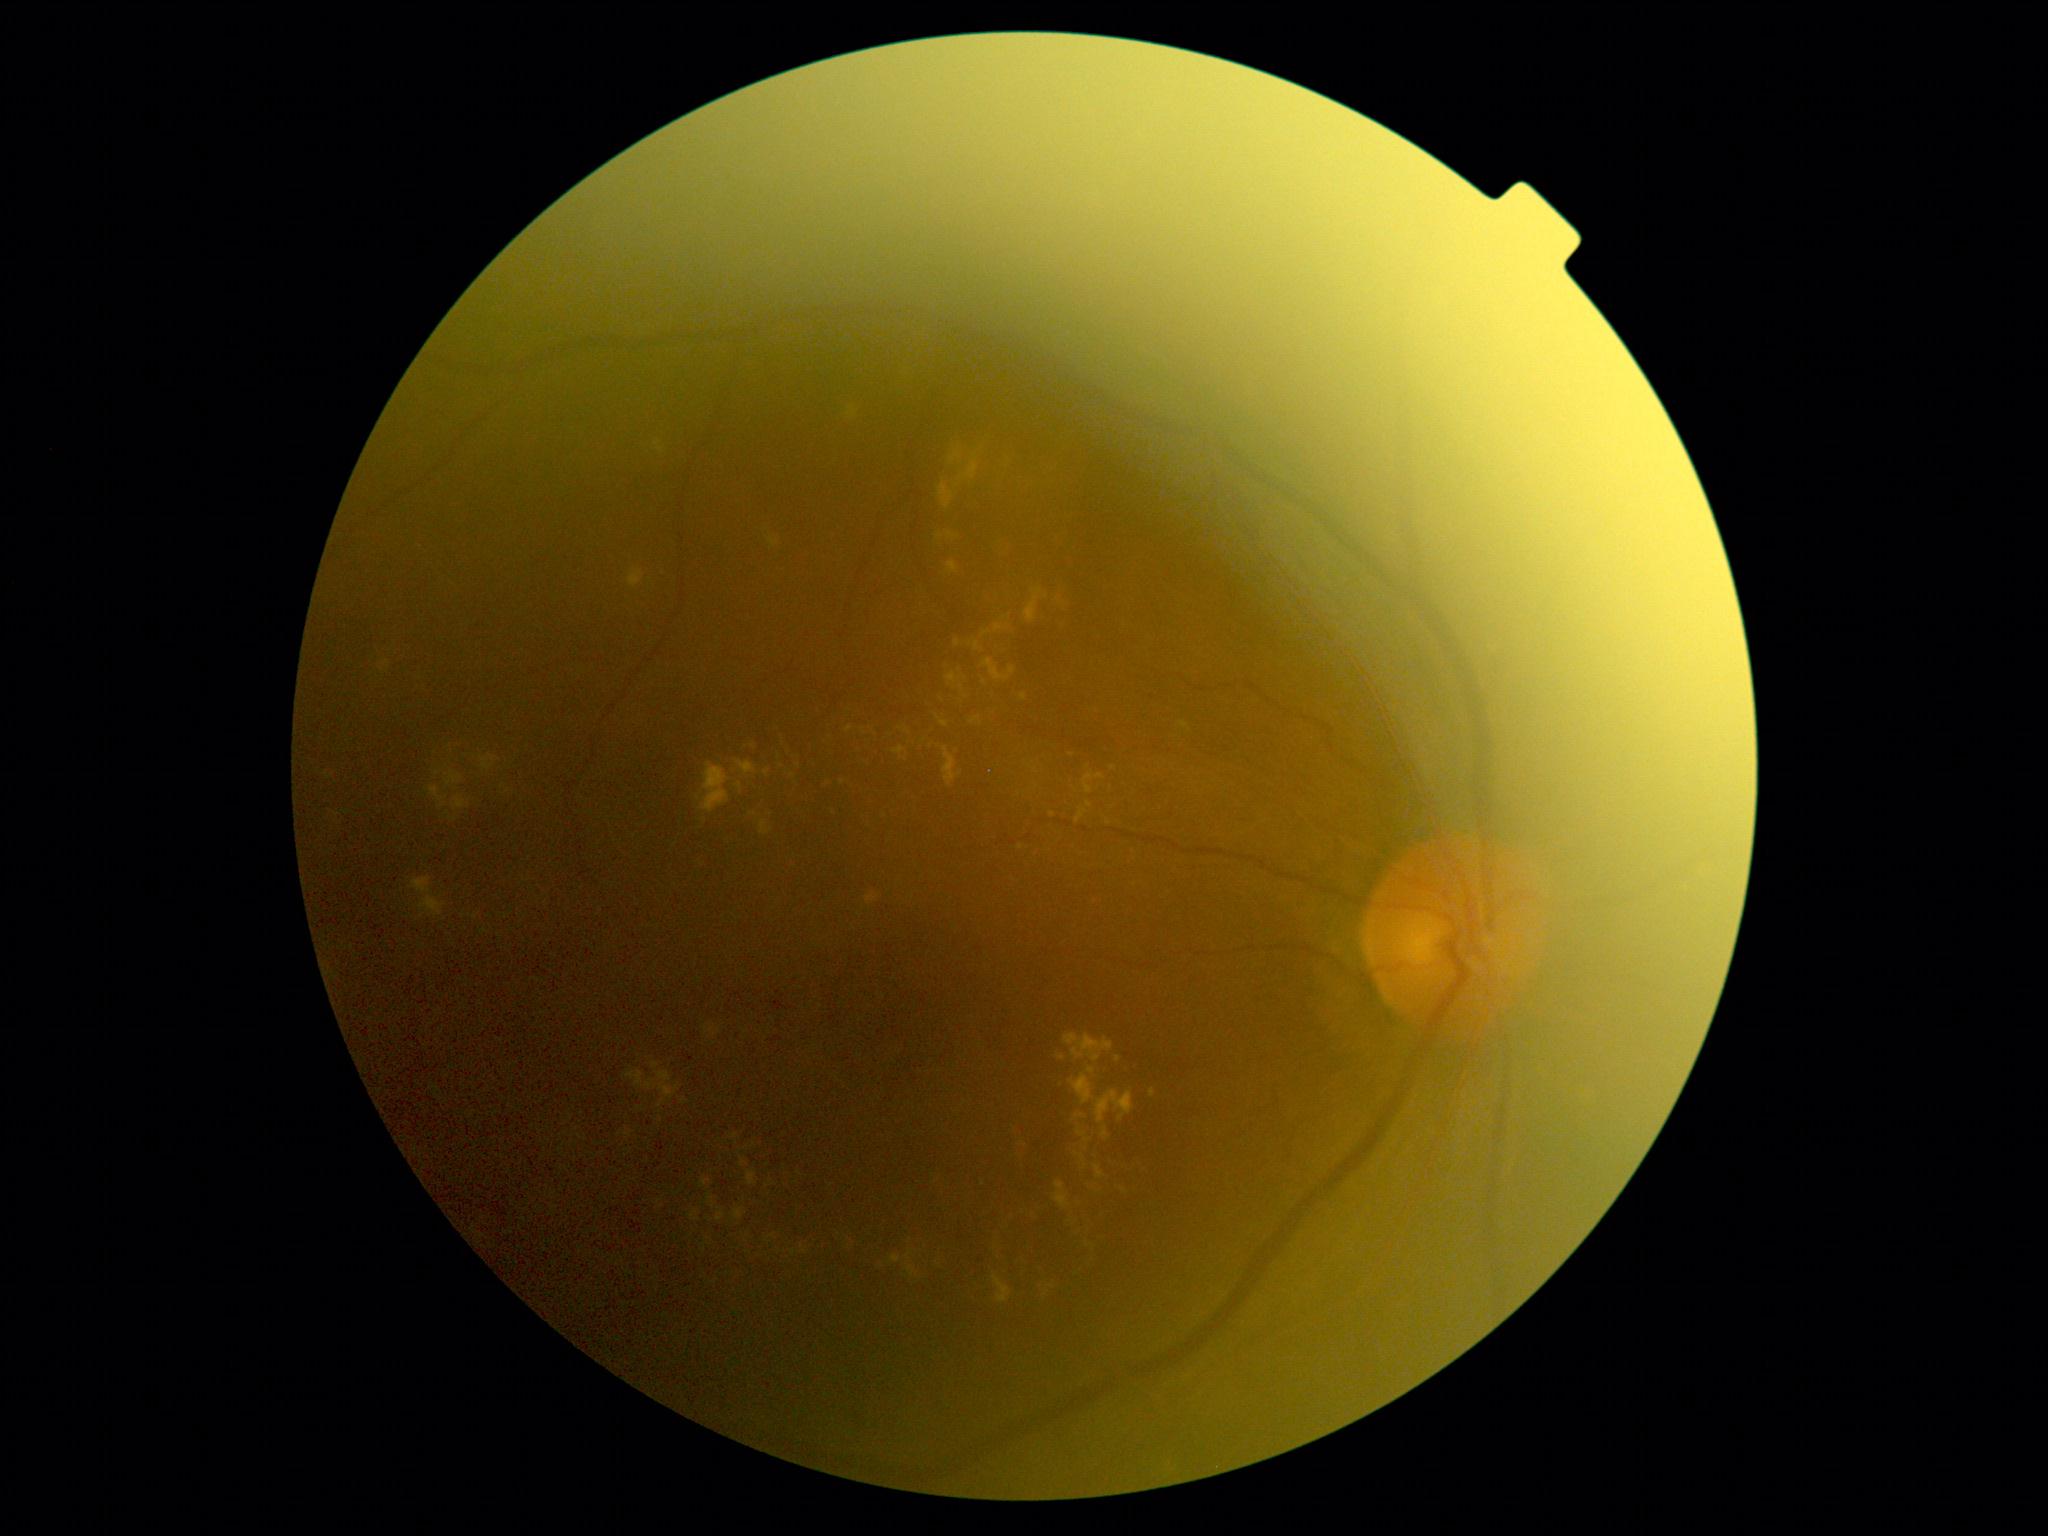 partial: true
dr_grade: 2
dr_grade_name: moderate NPDR
lesions:
  ex:
    - bbox=[382, 661, 390, 668]
    - bbox=[1081, 1155, 1085, 1163]
    - bbox=[829, 804, 835, 817]
    - bbox=[1055, 585, 1065, 621]
    - bbox=[410, 877, 446, 919]
    - bbox=[734, 1208, 746, 1221]
    - bbox=[1025, 588, 1049, 624]
    - bbox=[760, 822, 773, 836]
    - bbox=[893, 747, 906, 756]
    - bbox=[482, 755, 498, 771]
    - bbox=[325, 773, 335, 780]
    - bbox=[1181, 721, 1191, 731]
    - bbox=[764, 769, 770, 777]
    - bbox=[931, 688, 959, 707]
  ex_small_approx:
    - [x=1114, y=769]
    - [x=903, y=758]
    - [x=984, y=683]
    - [x=781, y=767]
    - [x=1086, y=1149]
    - [x=1118, y=1059]